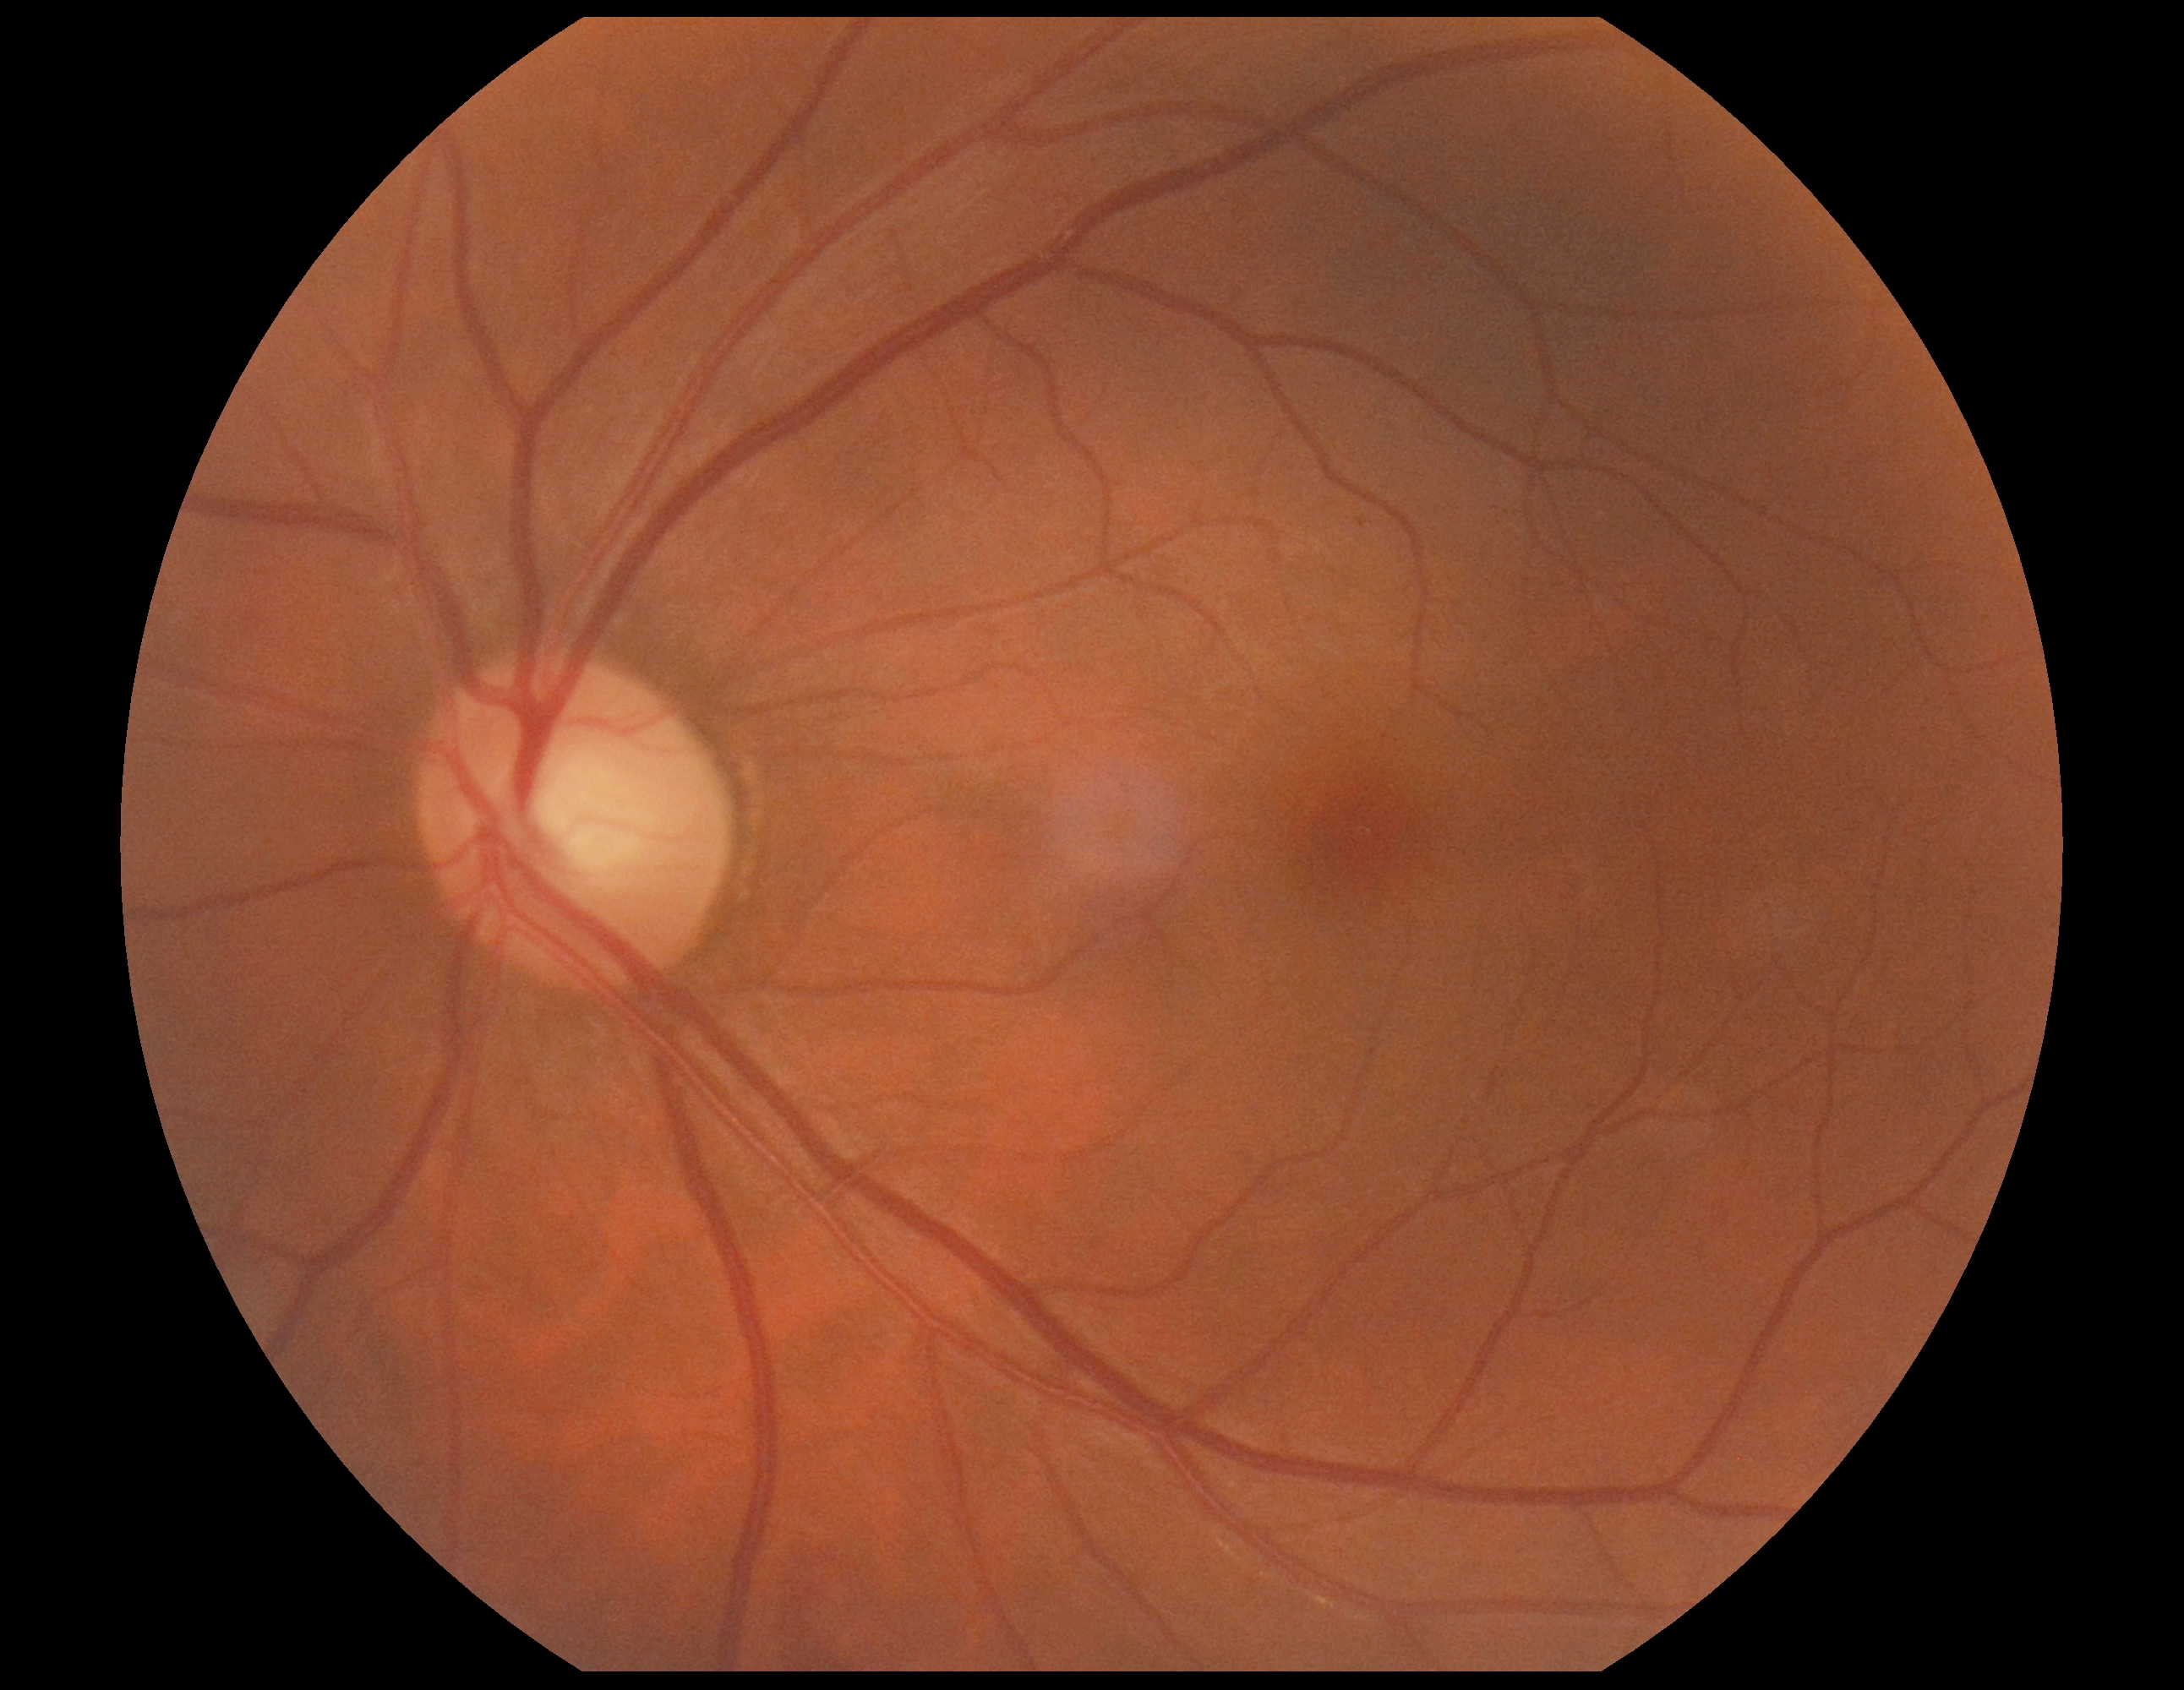 Disease class: non-proliferative diabetic retinopathy.
DR stage: grade 1 (mild NPDR).